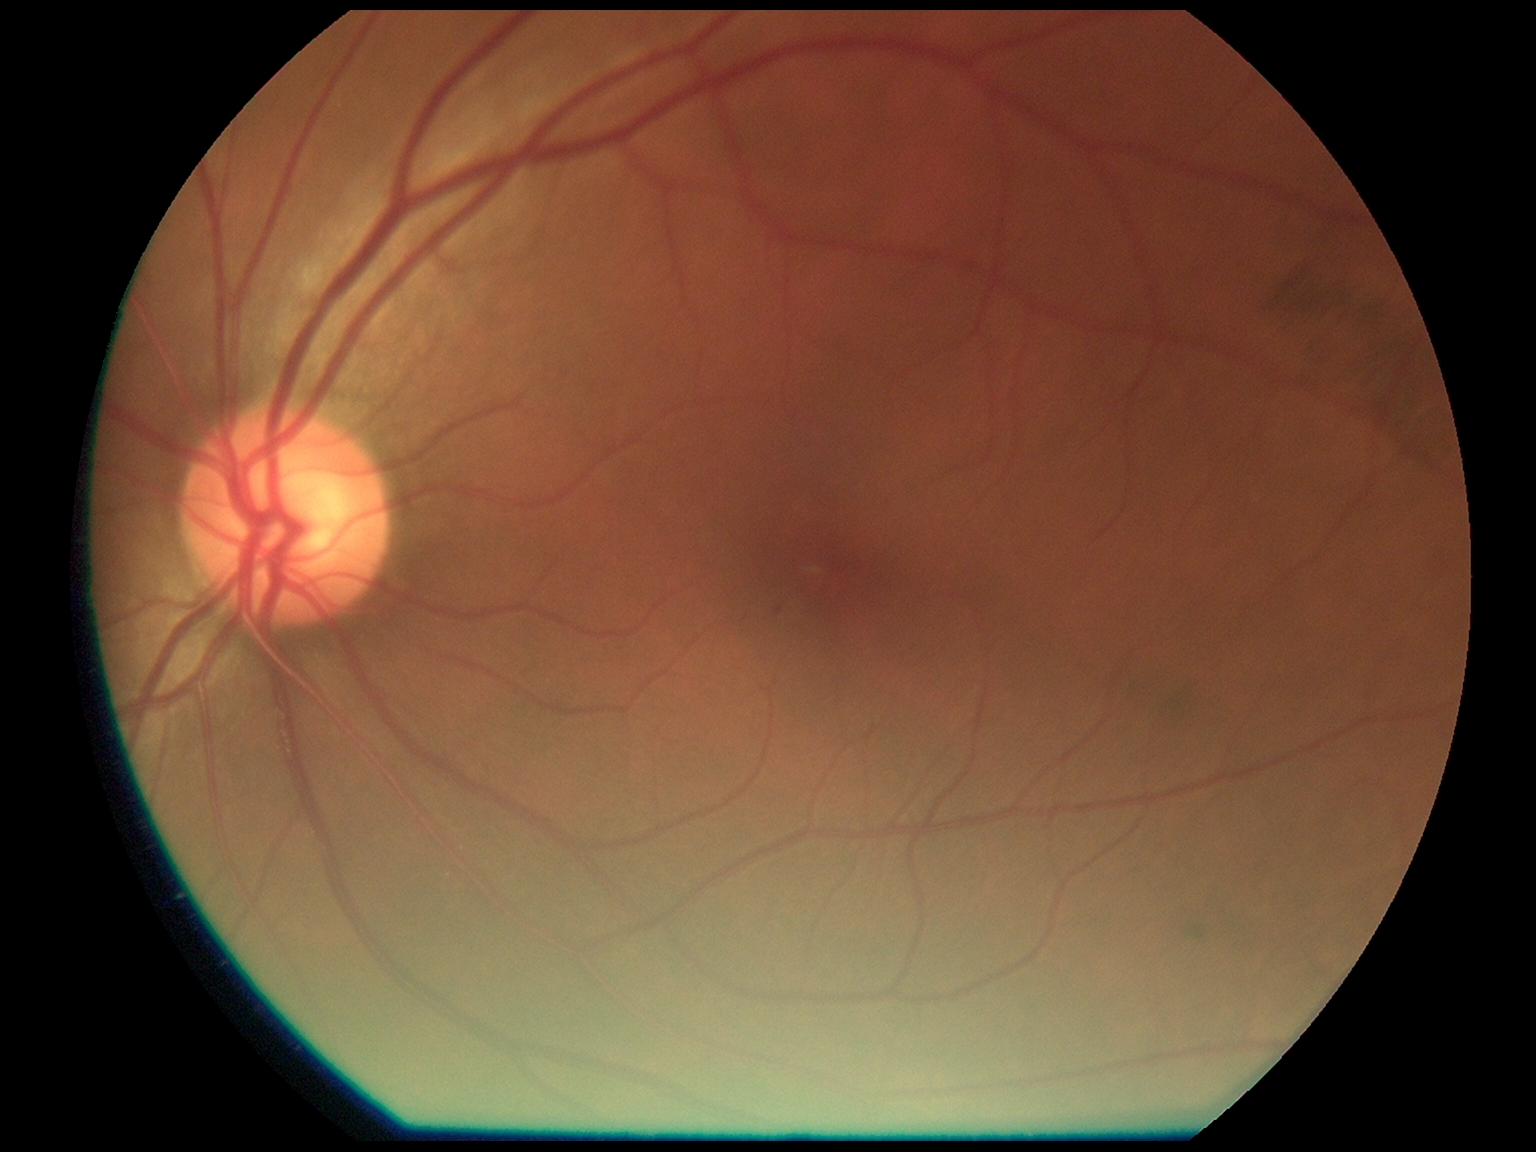

Disease class: non-proliferative diabetic retinopathy.
Retinopathy: grade 1.